Posterior pole photograph: 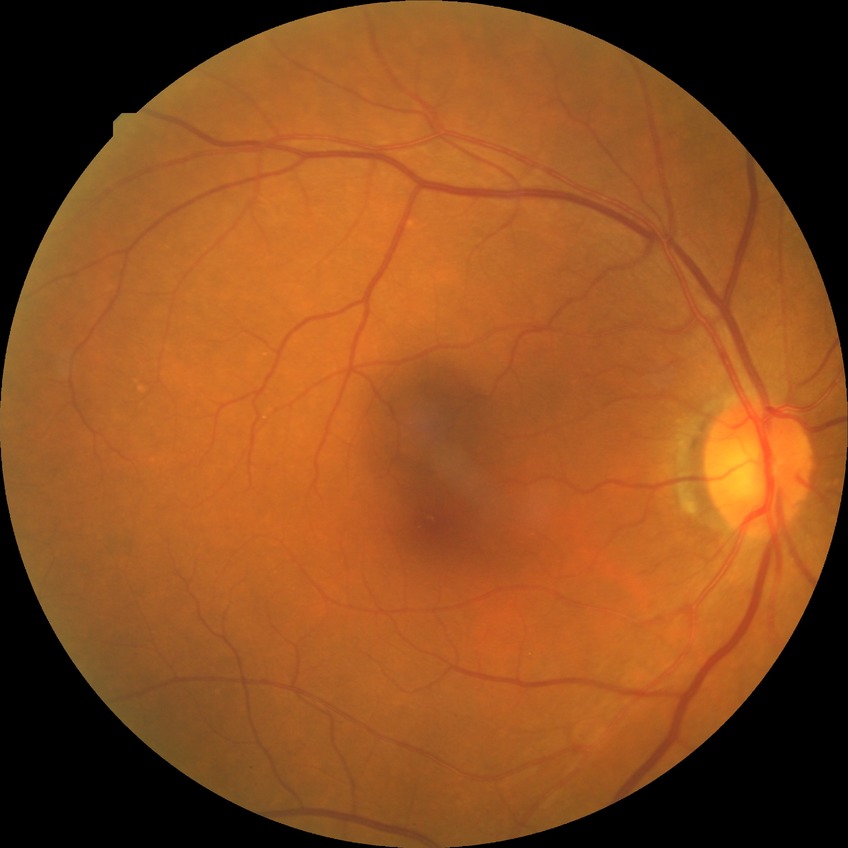 Findings:
• diabetic retinopathy (DR): no diabetic retinopathy (NDR)